Wide-field fundus image from infant ROP screening · Phoenix ICON, 100° FOV
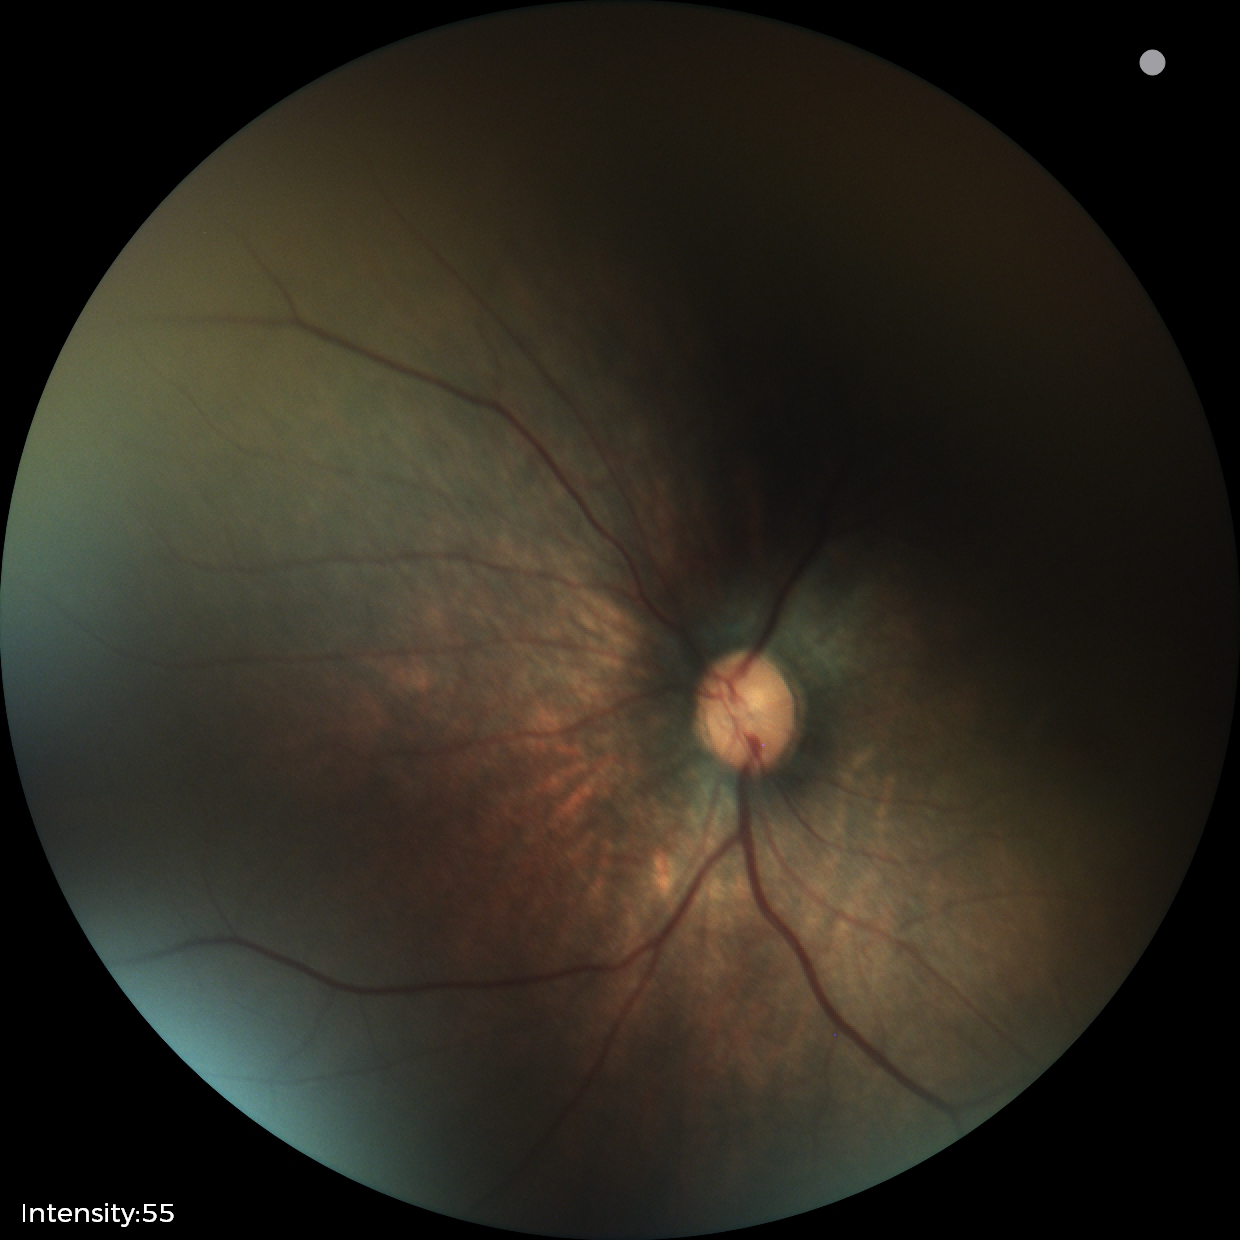 Screening examination with no abnormal retinal findings.